2212 x 1659 pixels: 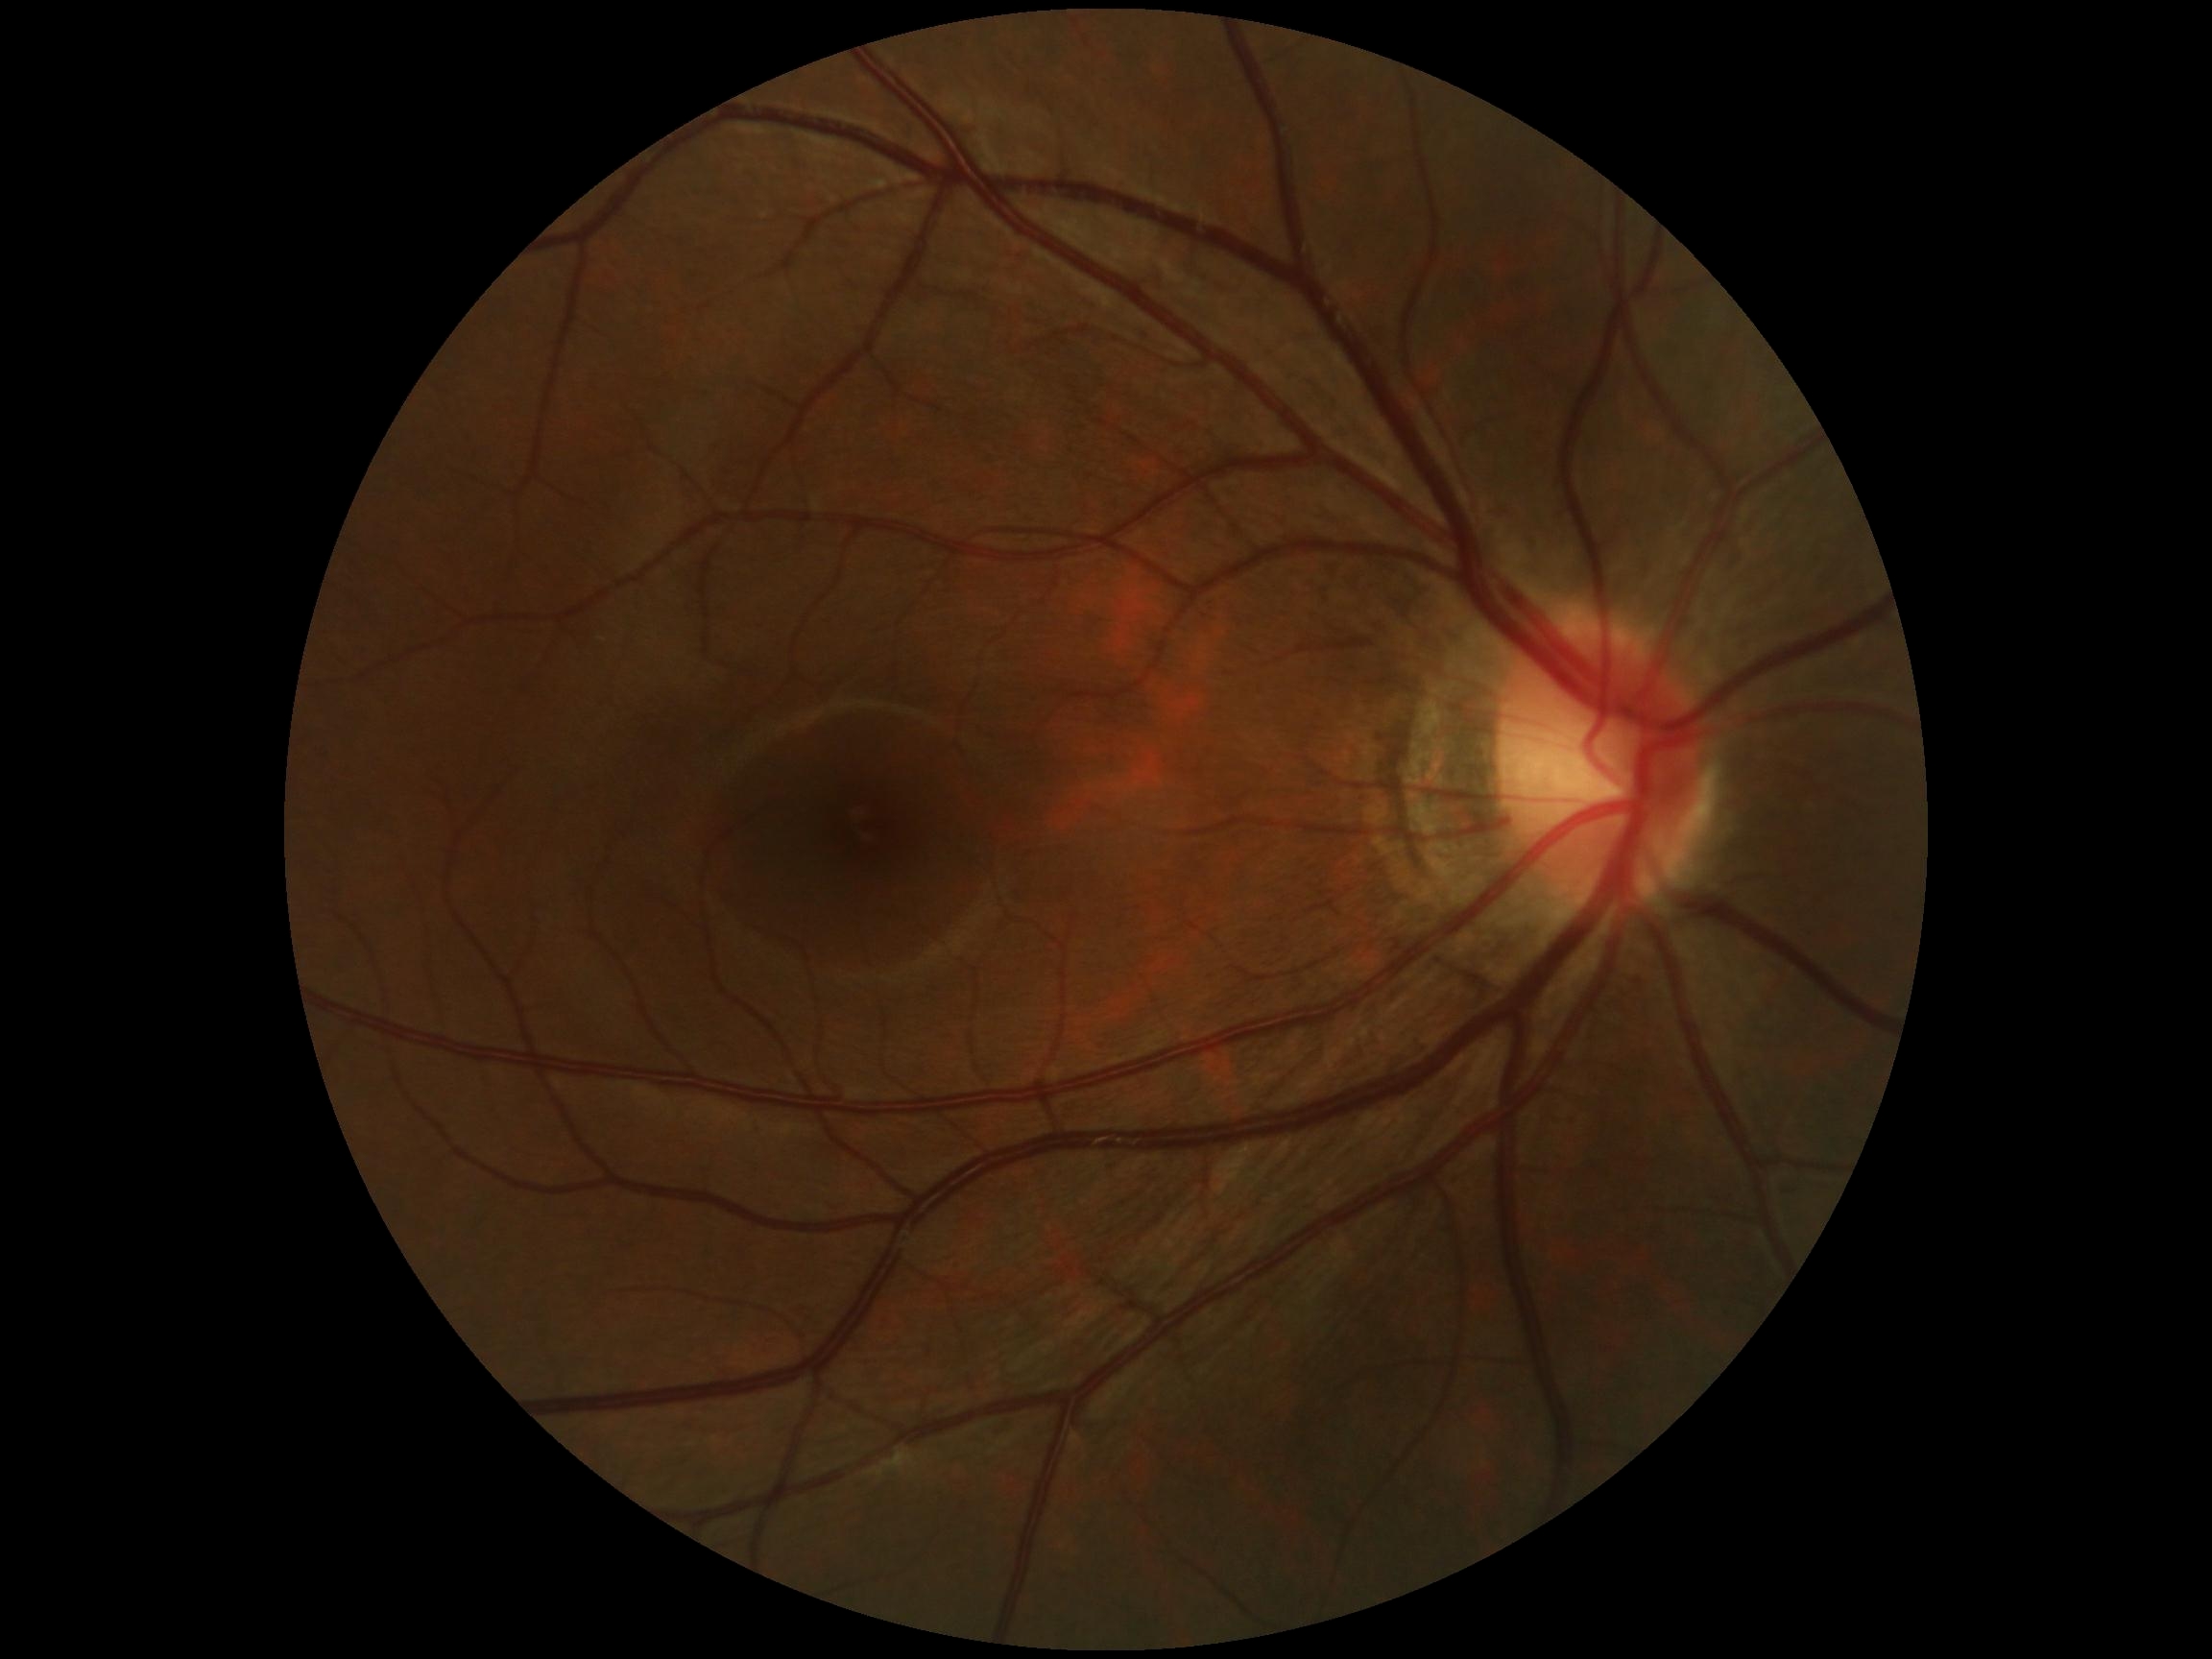 DR impression = no signs of DR
DR stage = grade 0 (no apparent retinopathy) — no visible signs of diabetic retinopathy